1932x1916px, color fundus image, 45-degree field of view — 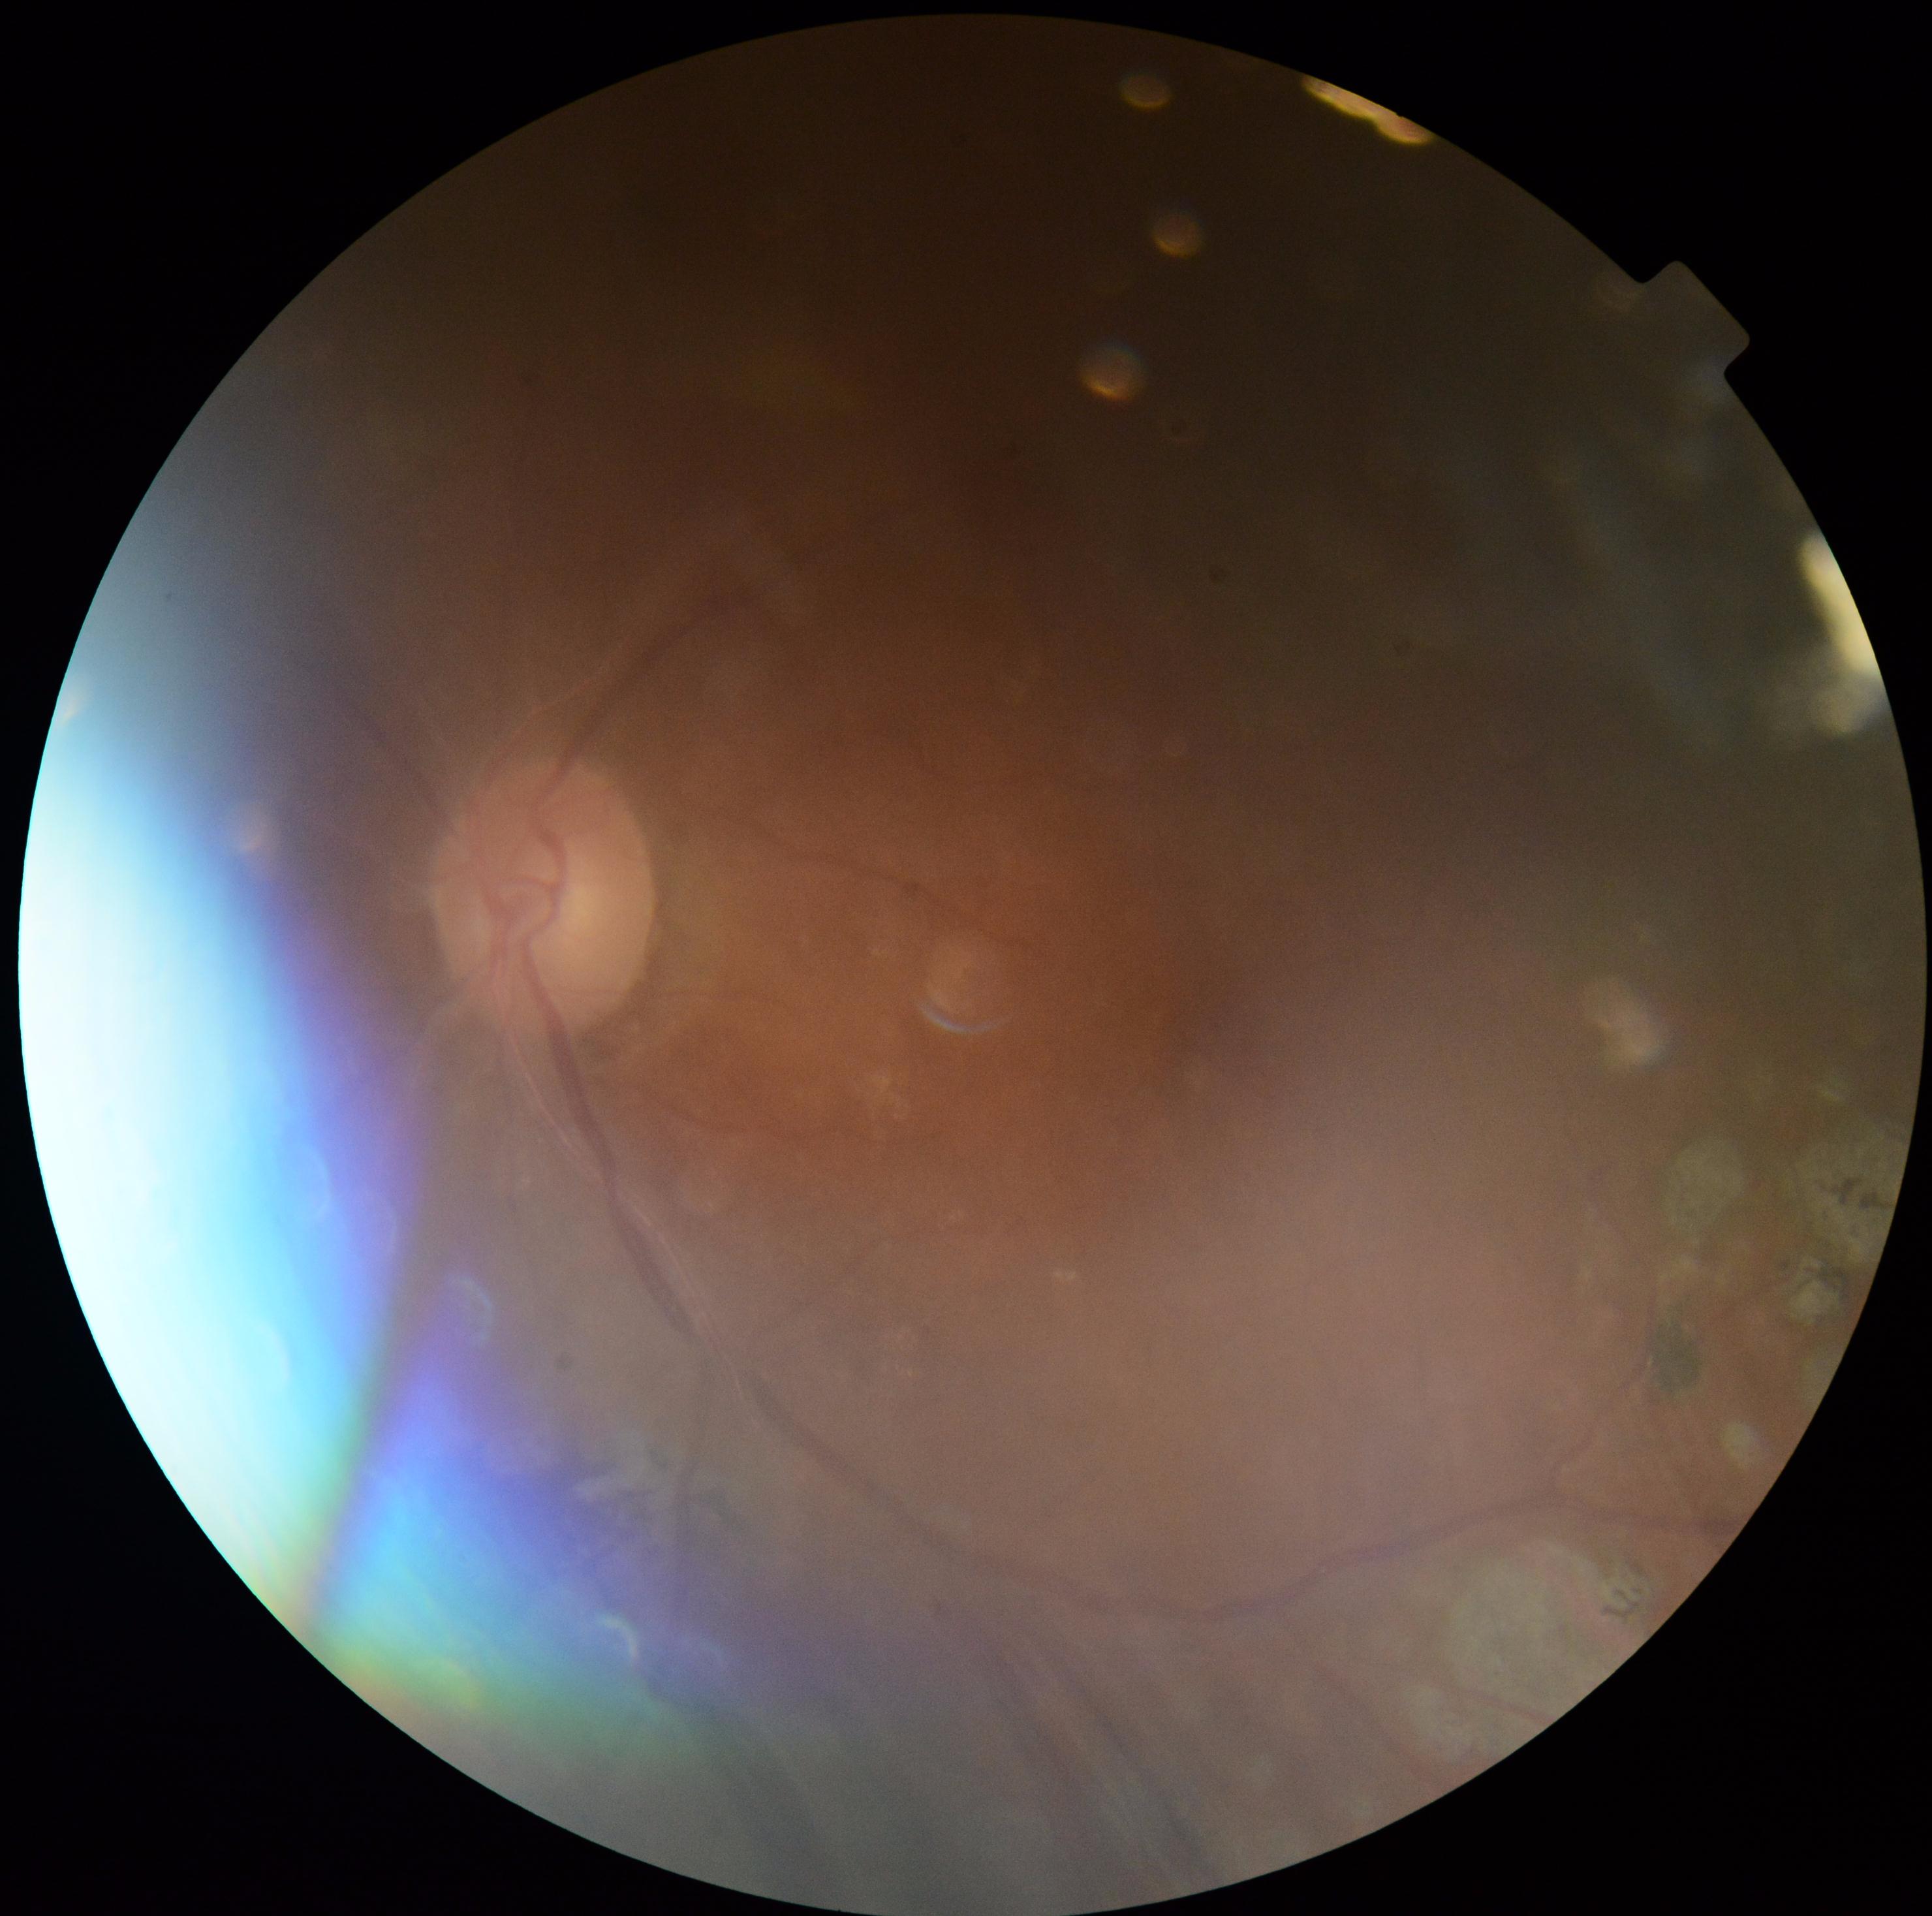
The image cannot be graded for diabetic retinopathy.
Diabetic retinopathy grade is ungradable due to poor image quality.